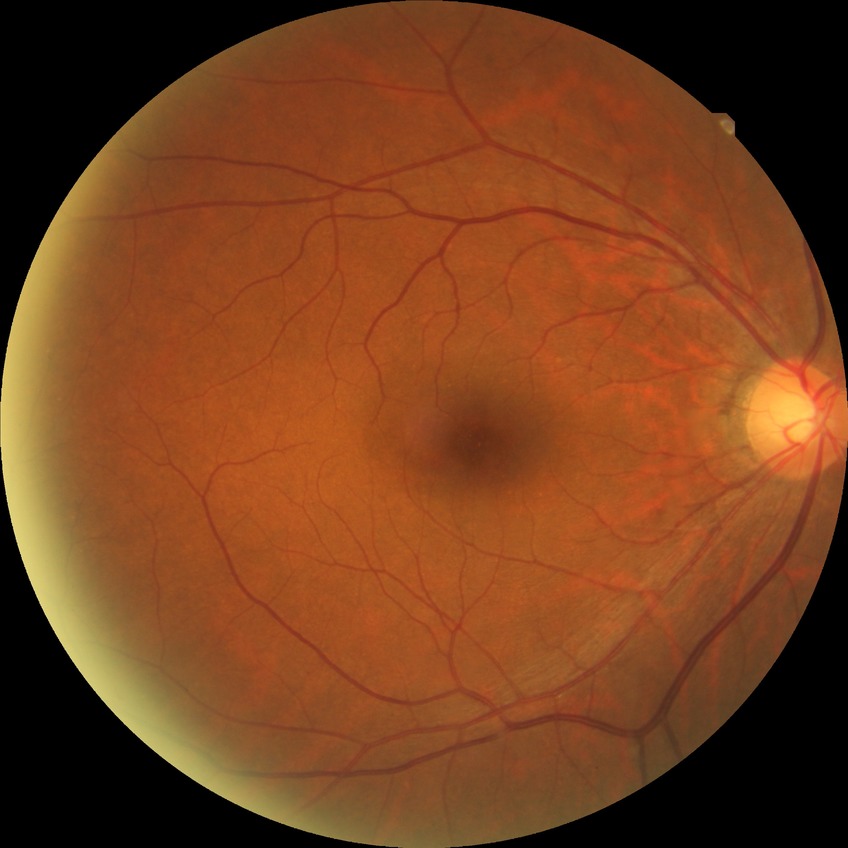

DR grade: NDR. No diabetic retinal disease findings.